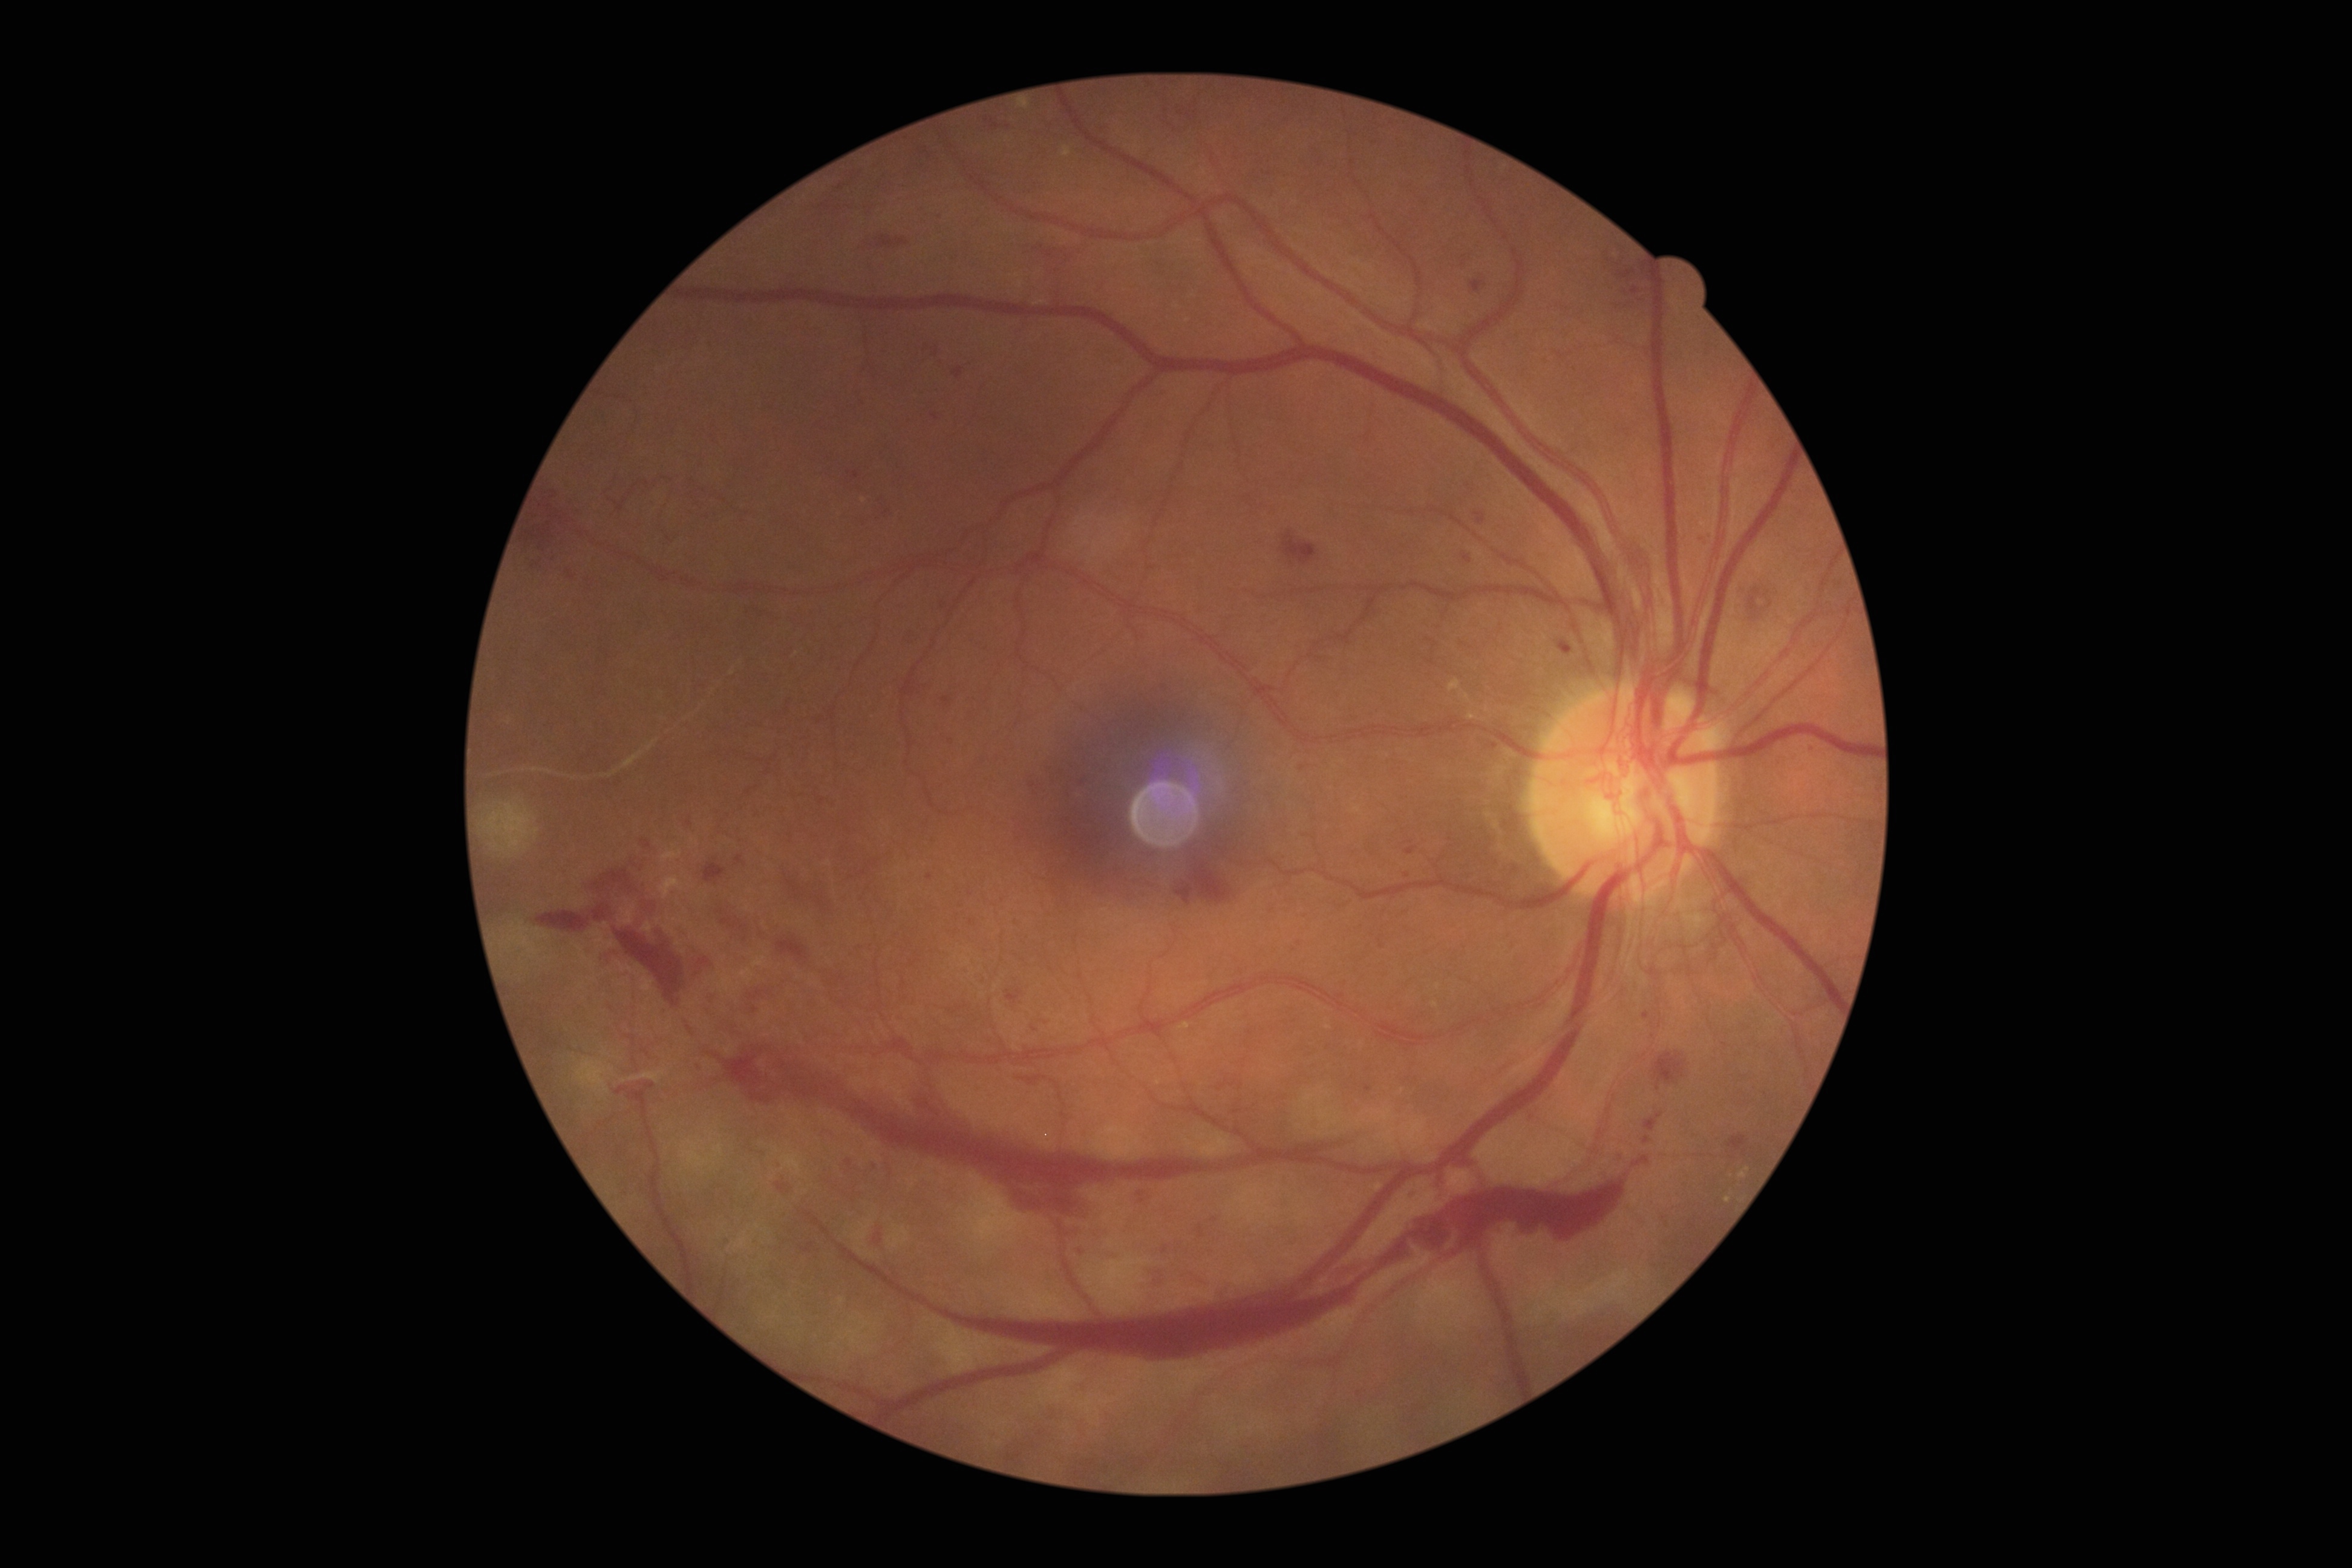

diabetic retinopathy severity@PDR (grade 4).